512x512px: 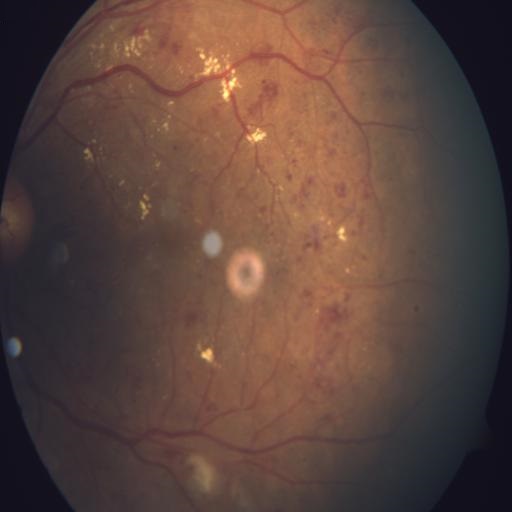
This fundus photograph shows hemorrhagic retinopathy, cotton wool spots, macular edema, and exudation.